Nonmydriatic fundus photograph · 848x848.
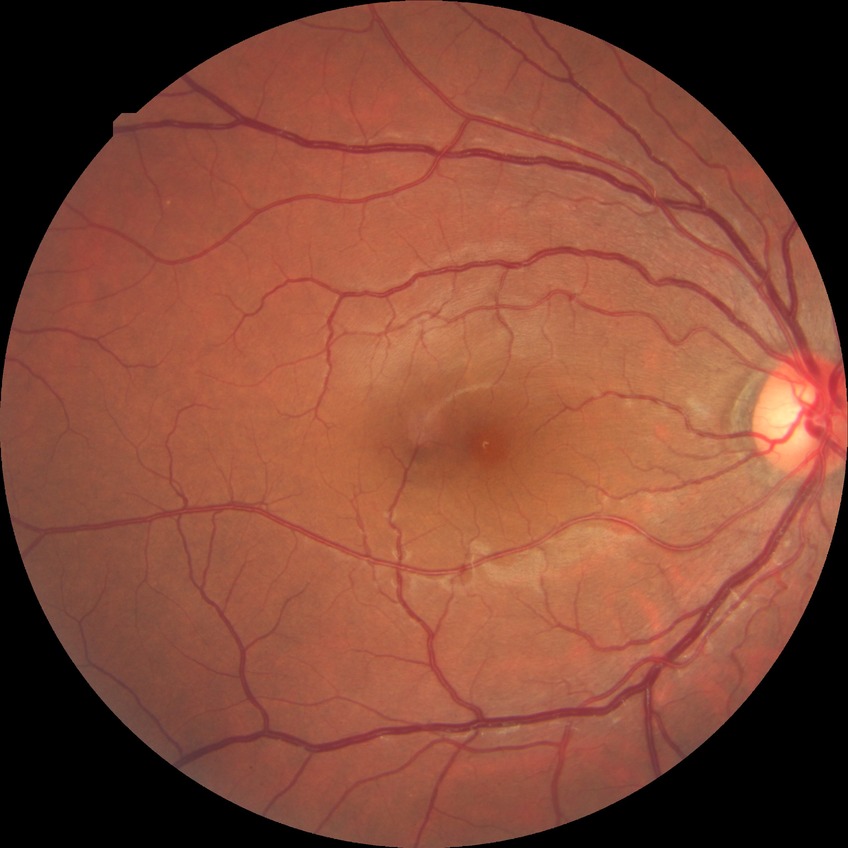

Diabetic retinopathy (DR): no diabetic retinopathy (NDR).